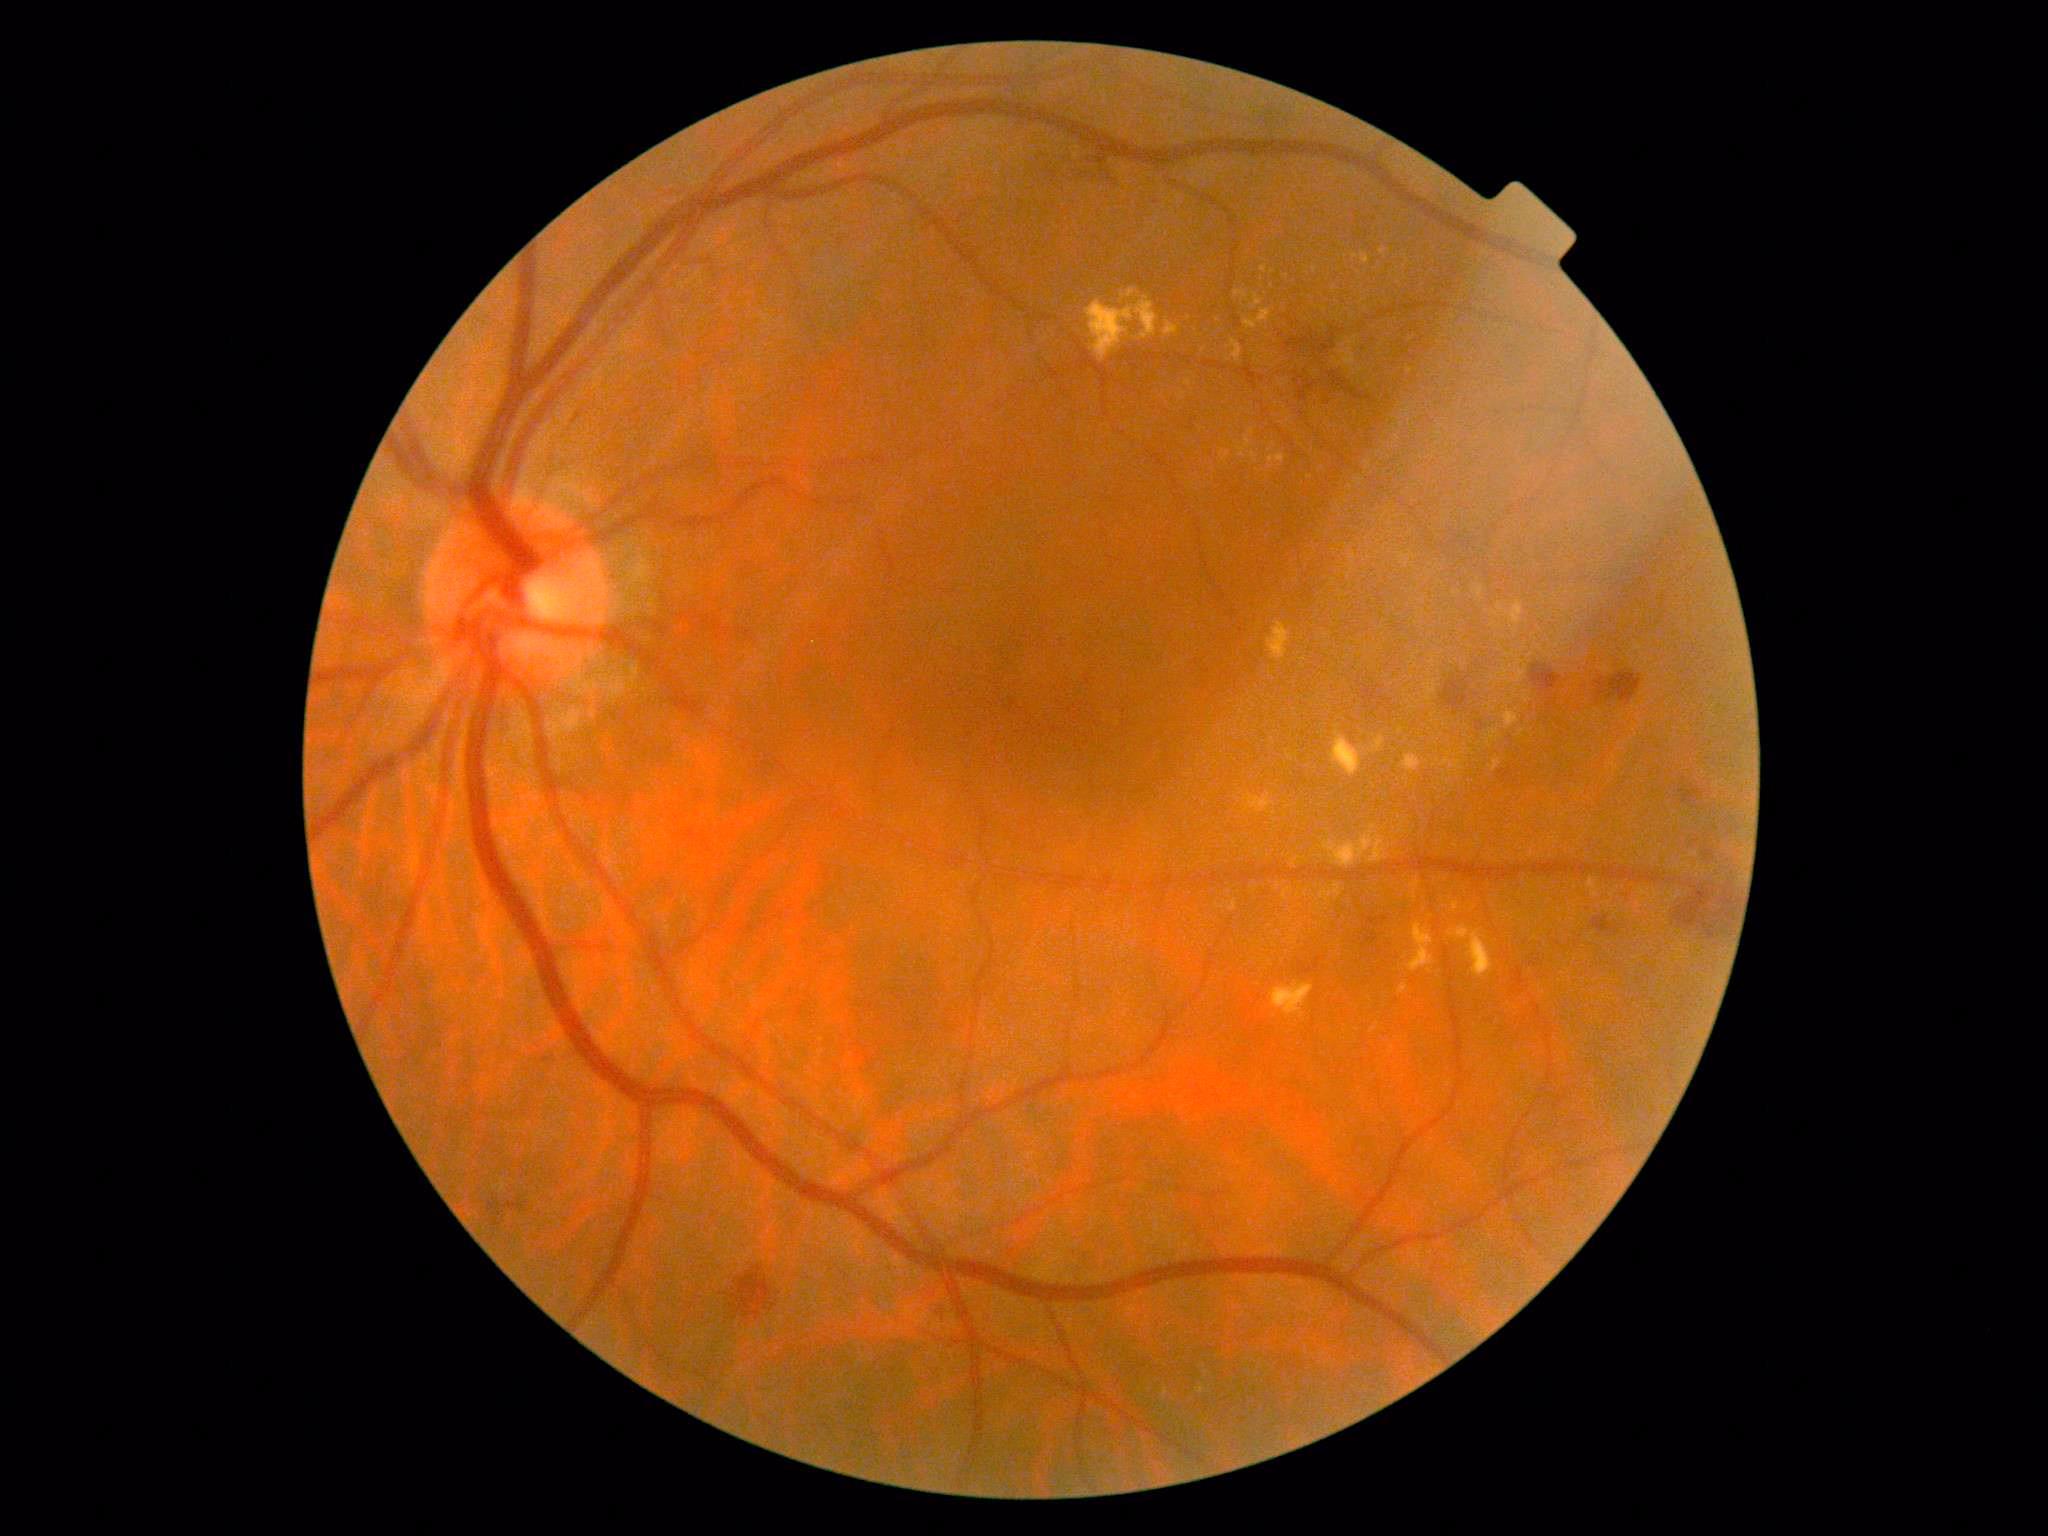 DR severity is 2.